Camera: NIDEK AFC-230.
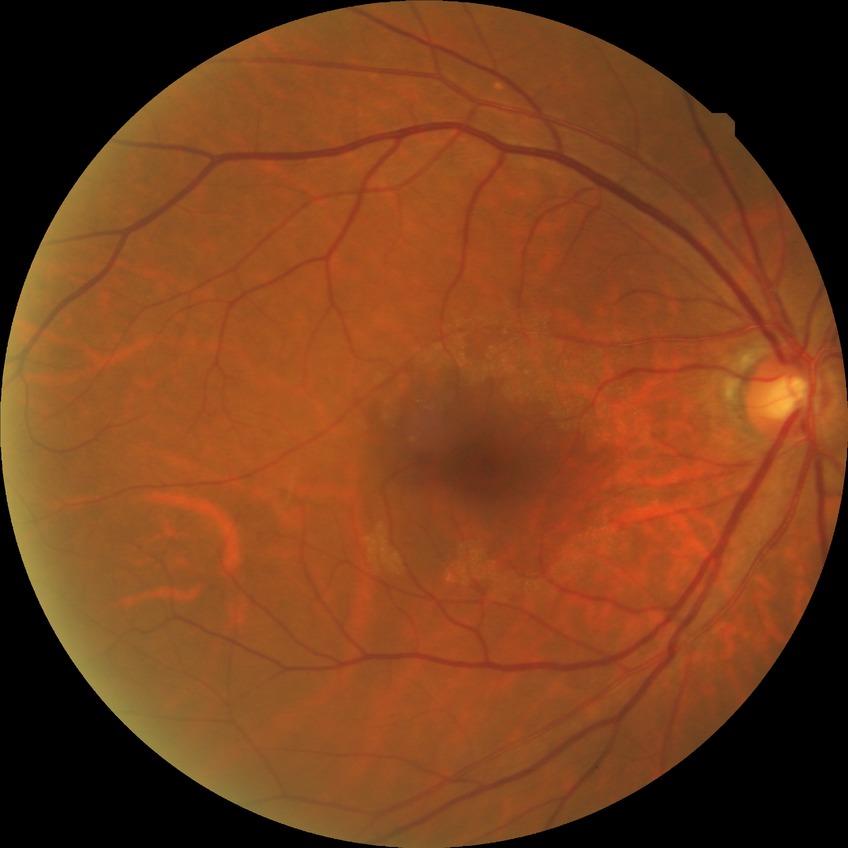

{
  "davis_grade": "no diabetic retinopathy"
}